DR severity per modified Davis staging
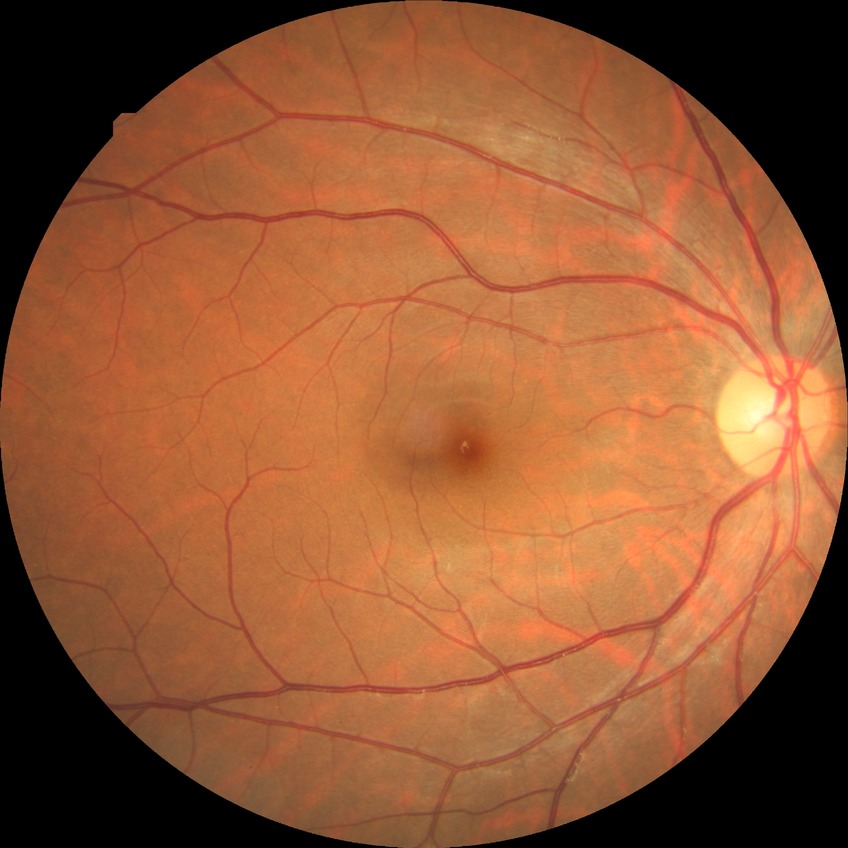   davis_grade: NDR